Retinal fundus photograph · 45° FOV · diabetic retinopathy graded by the modified Davis classification · 848x848px:
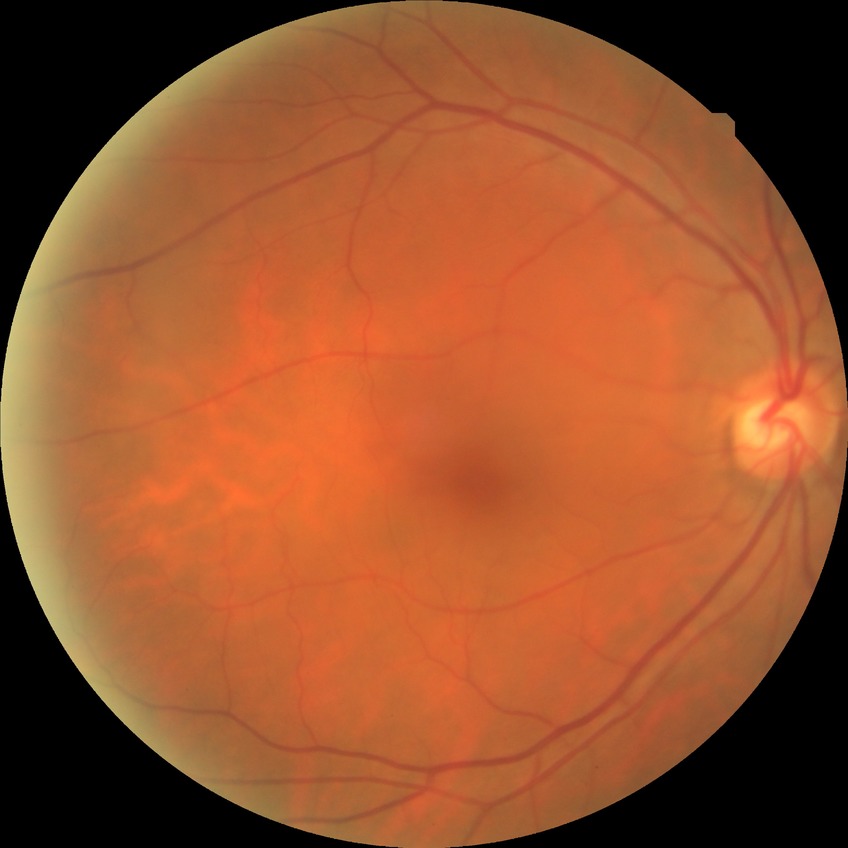
Assessment:
* retinopathy stage: no diabetic retinopathy